45° field of view — 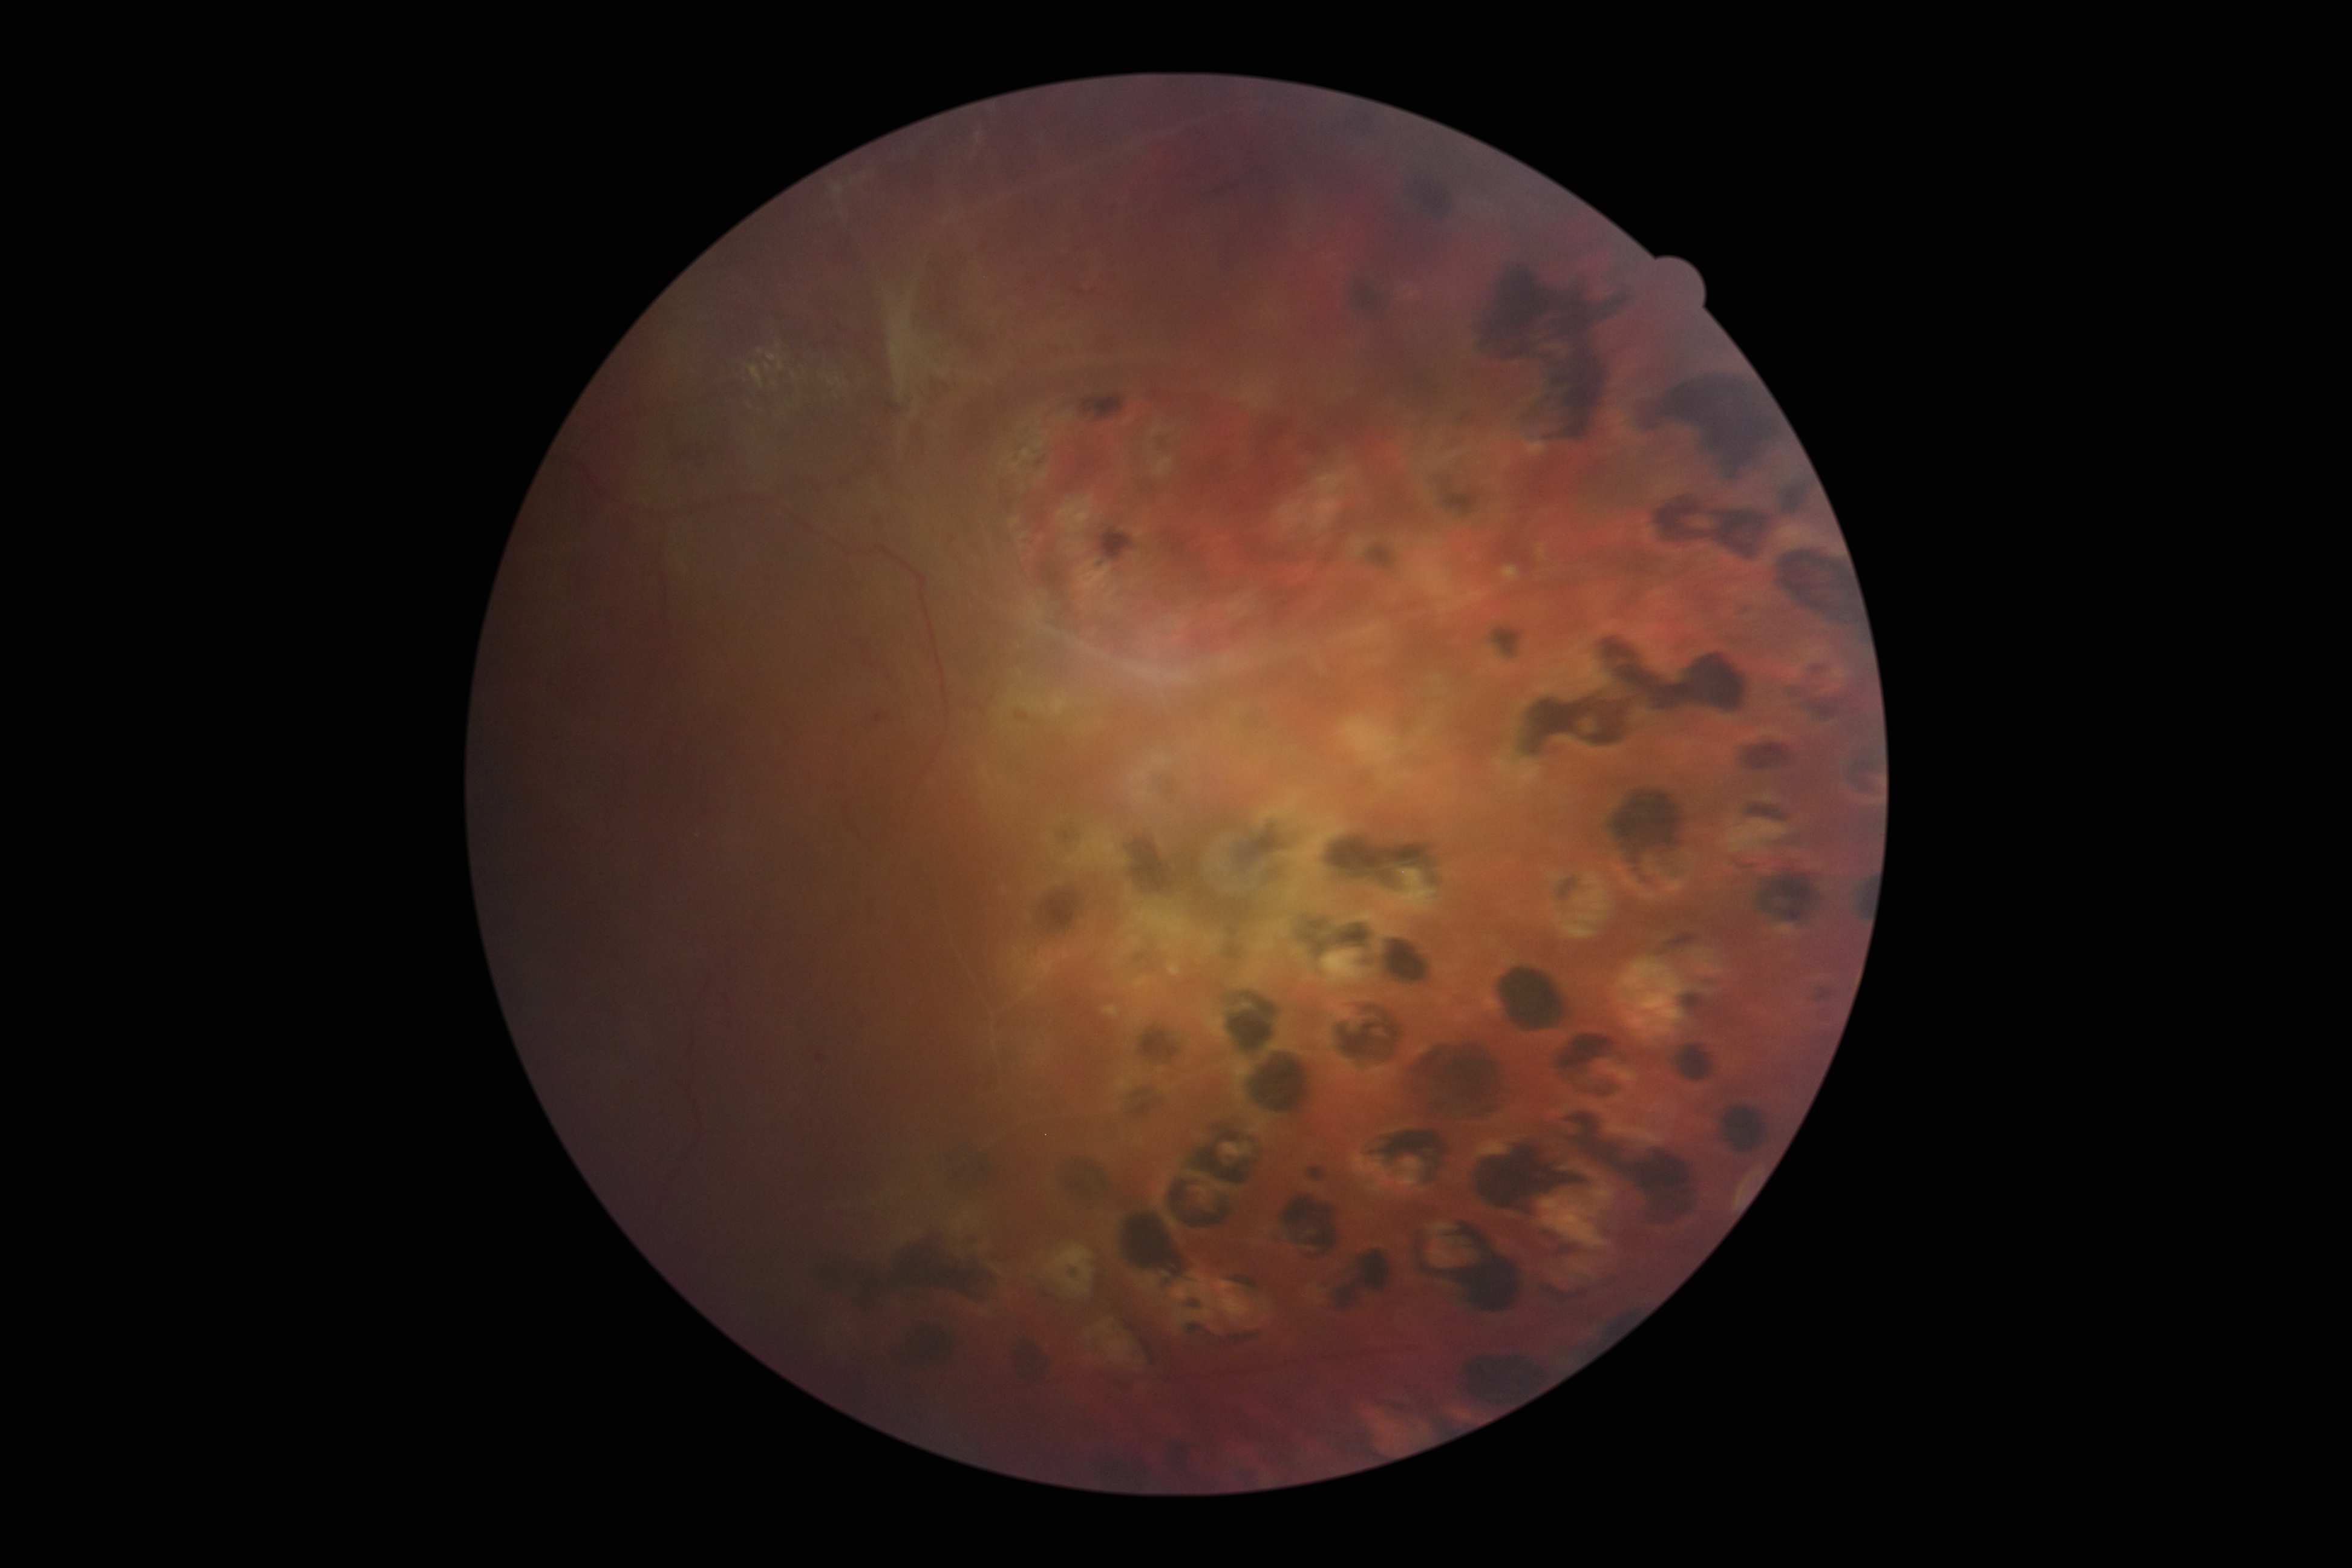

DR severity is grade 4 (PDR).